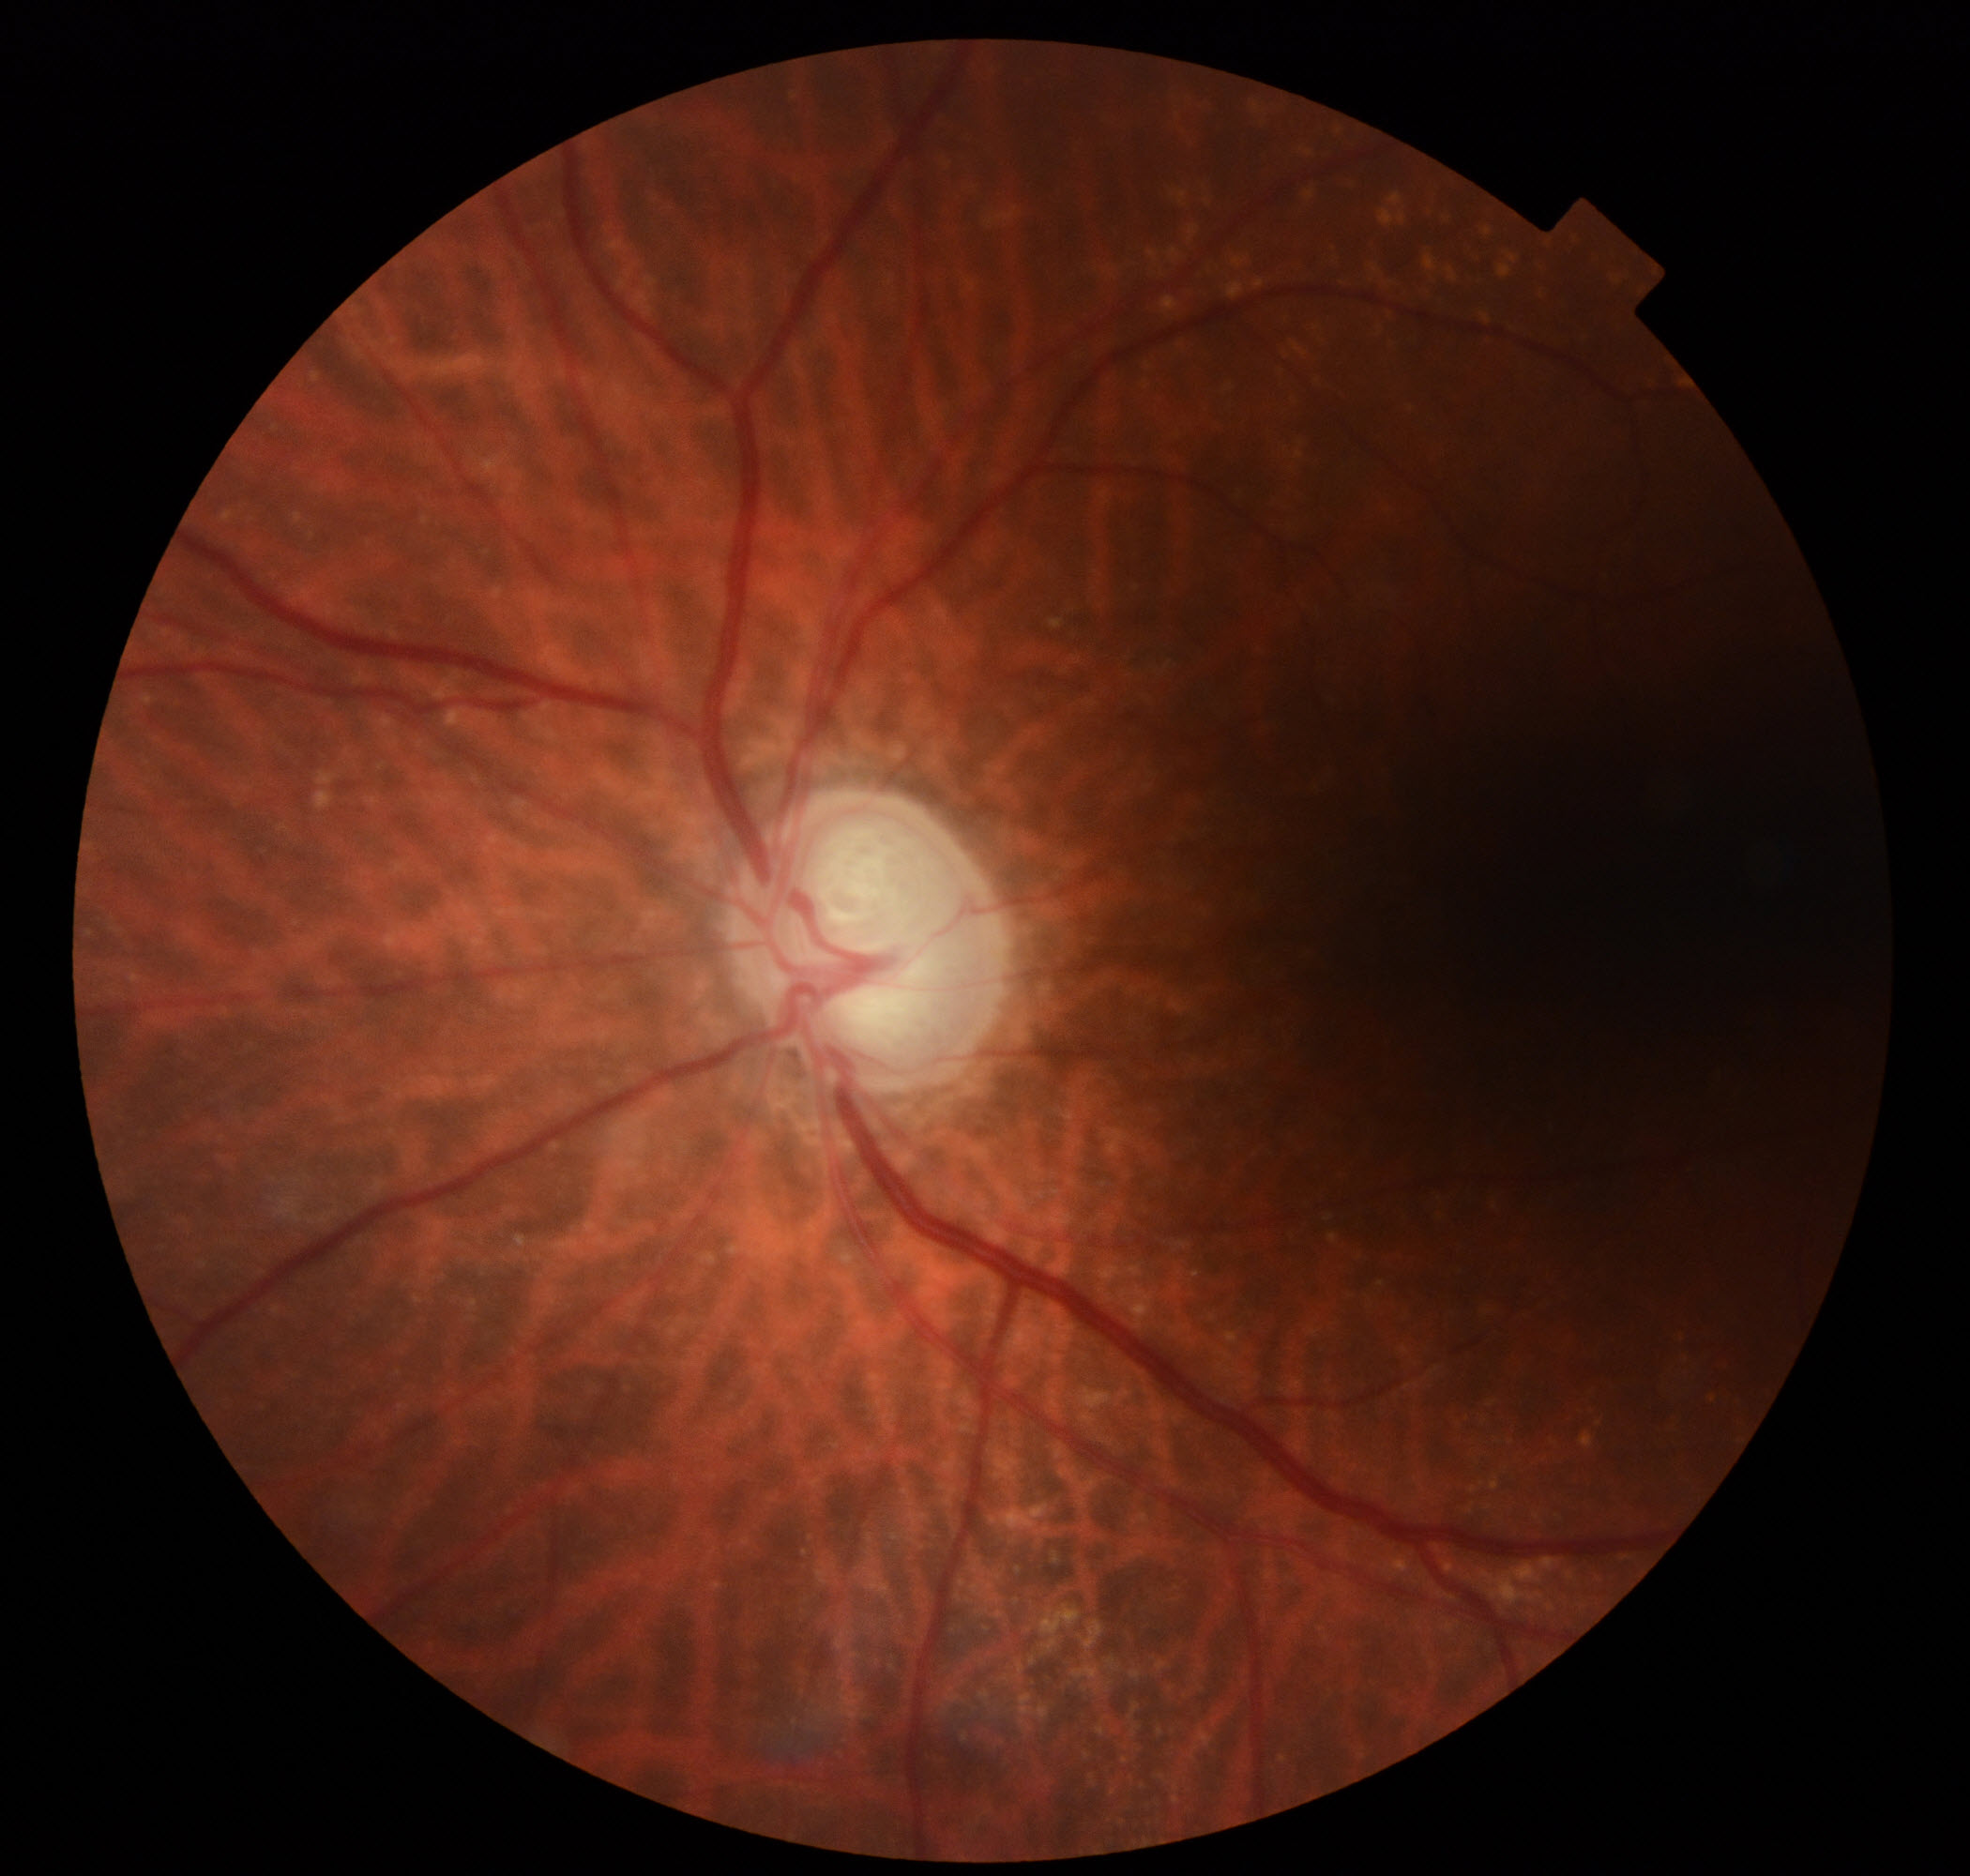

Appearance consistent with possible glaucoma.